45° FOV · camera: NIDEK AFC-230 · diabetic retinopathy graded by the modified Davis classification — 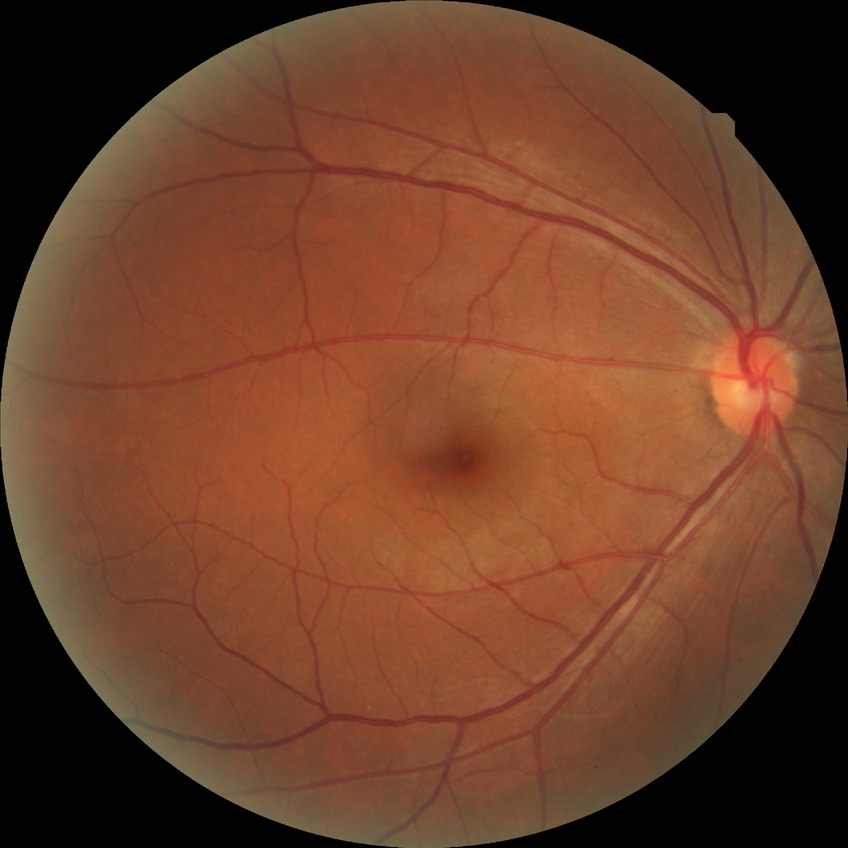

Modified Davis grading: no diabetic retinopathy.